Wide-field fundus photograph of an infant:
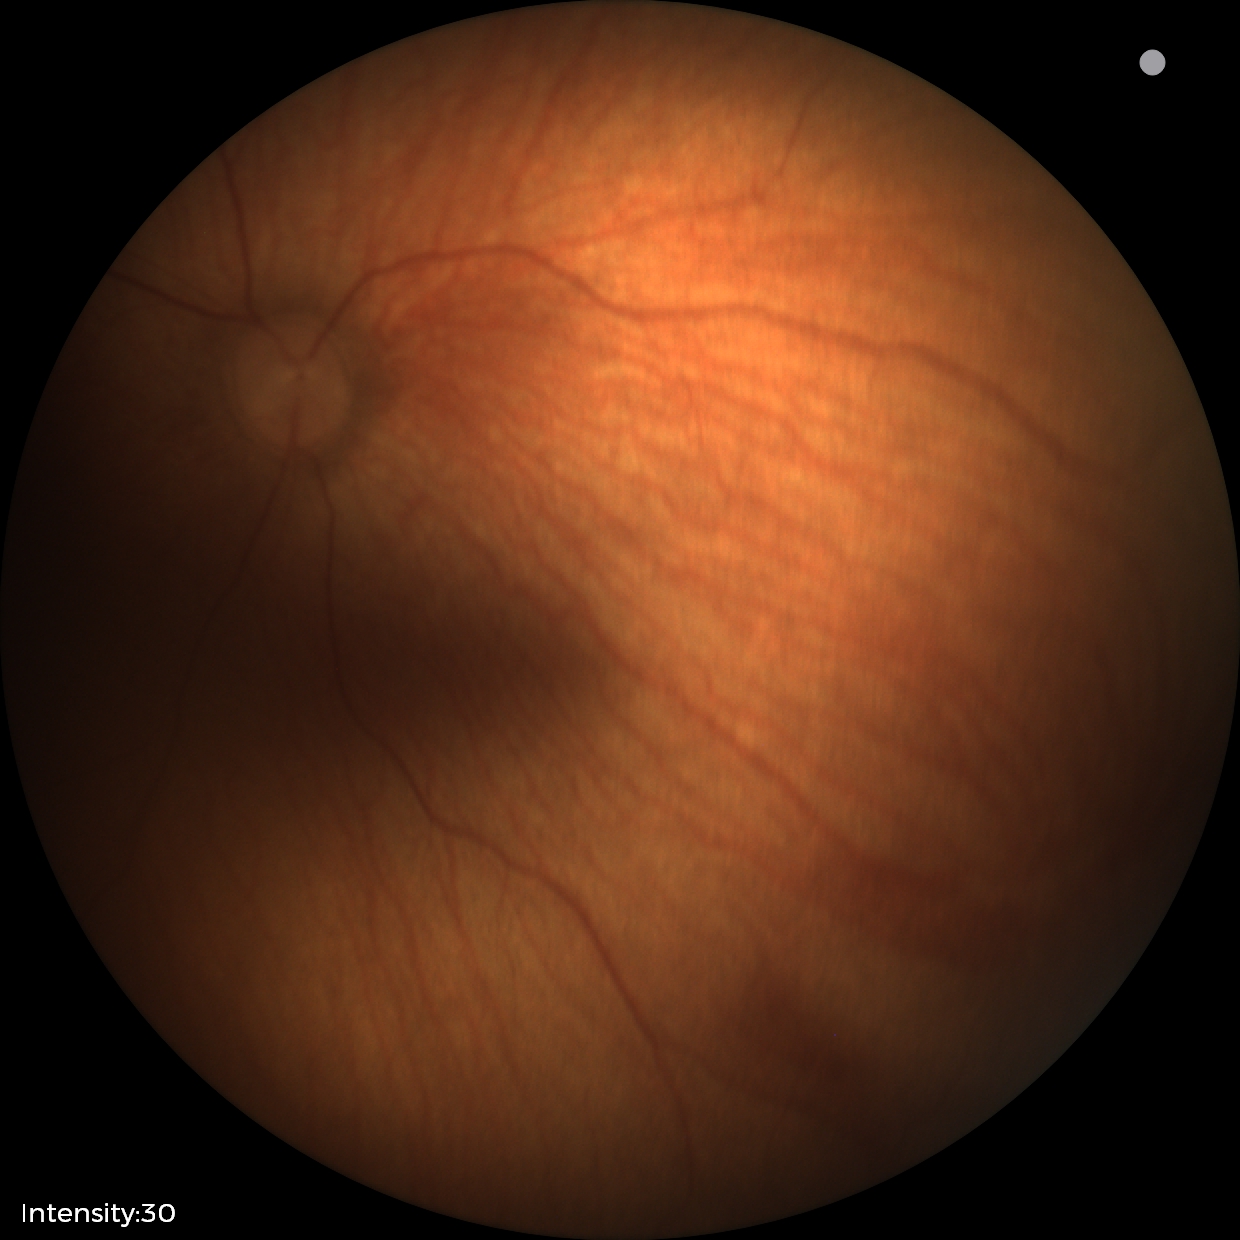

Diagnosis = no pathology identified.